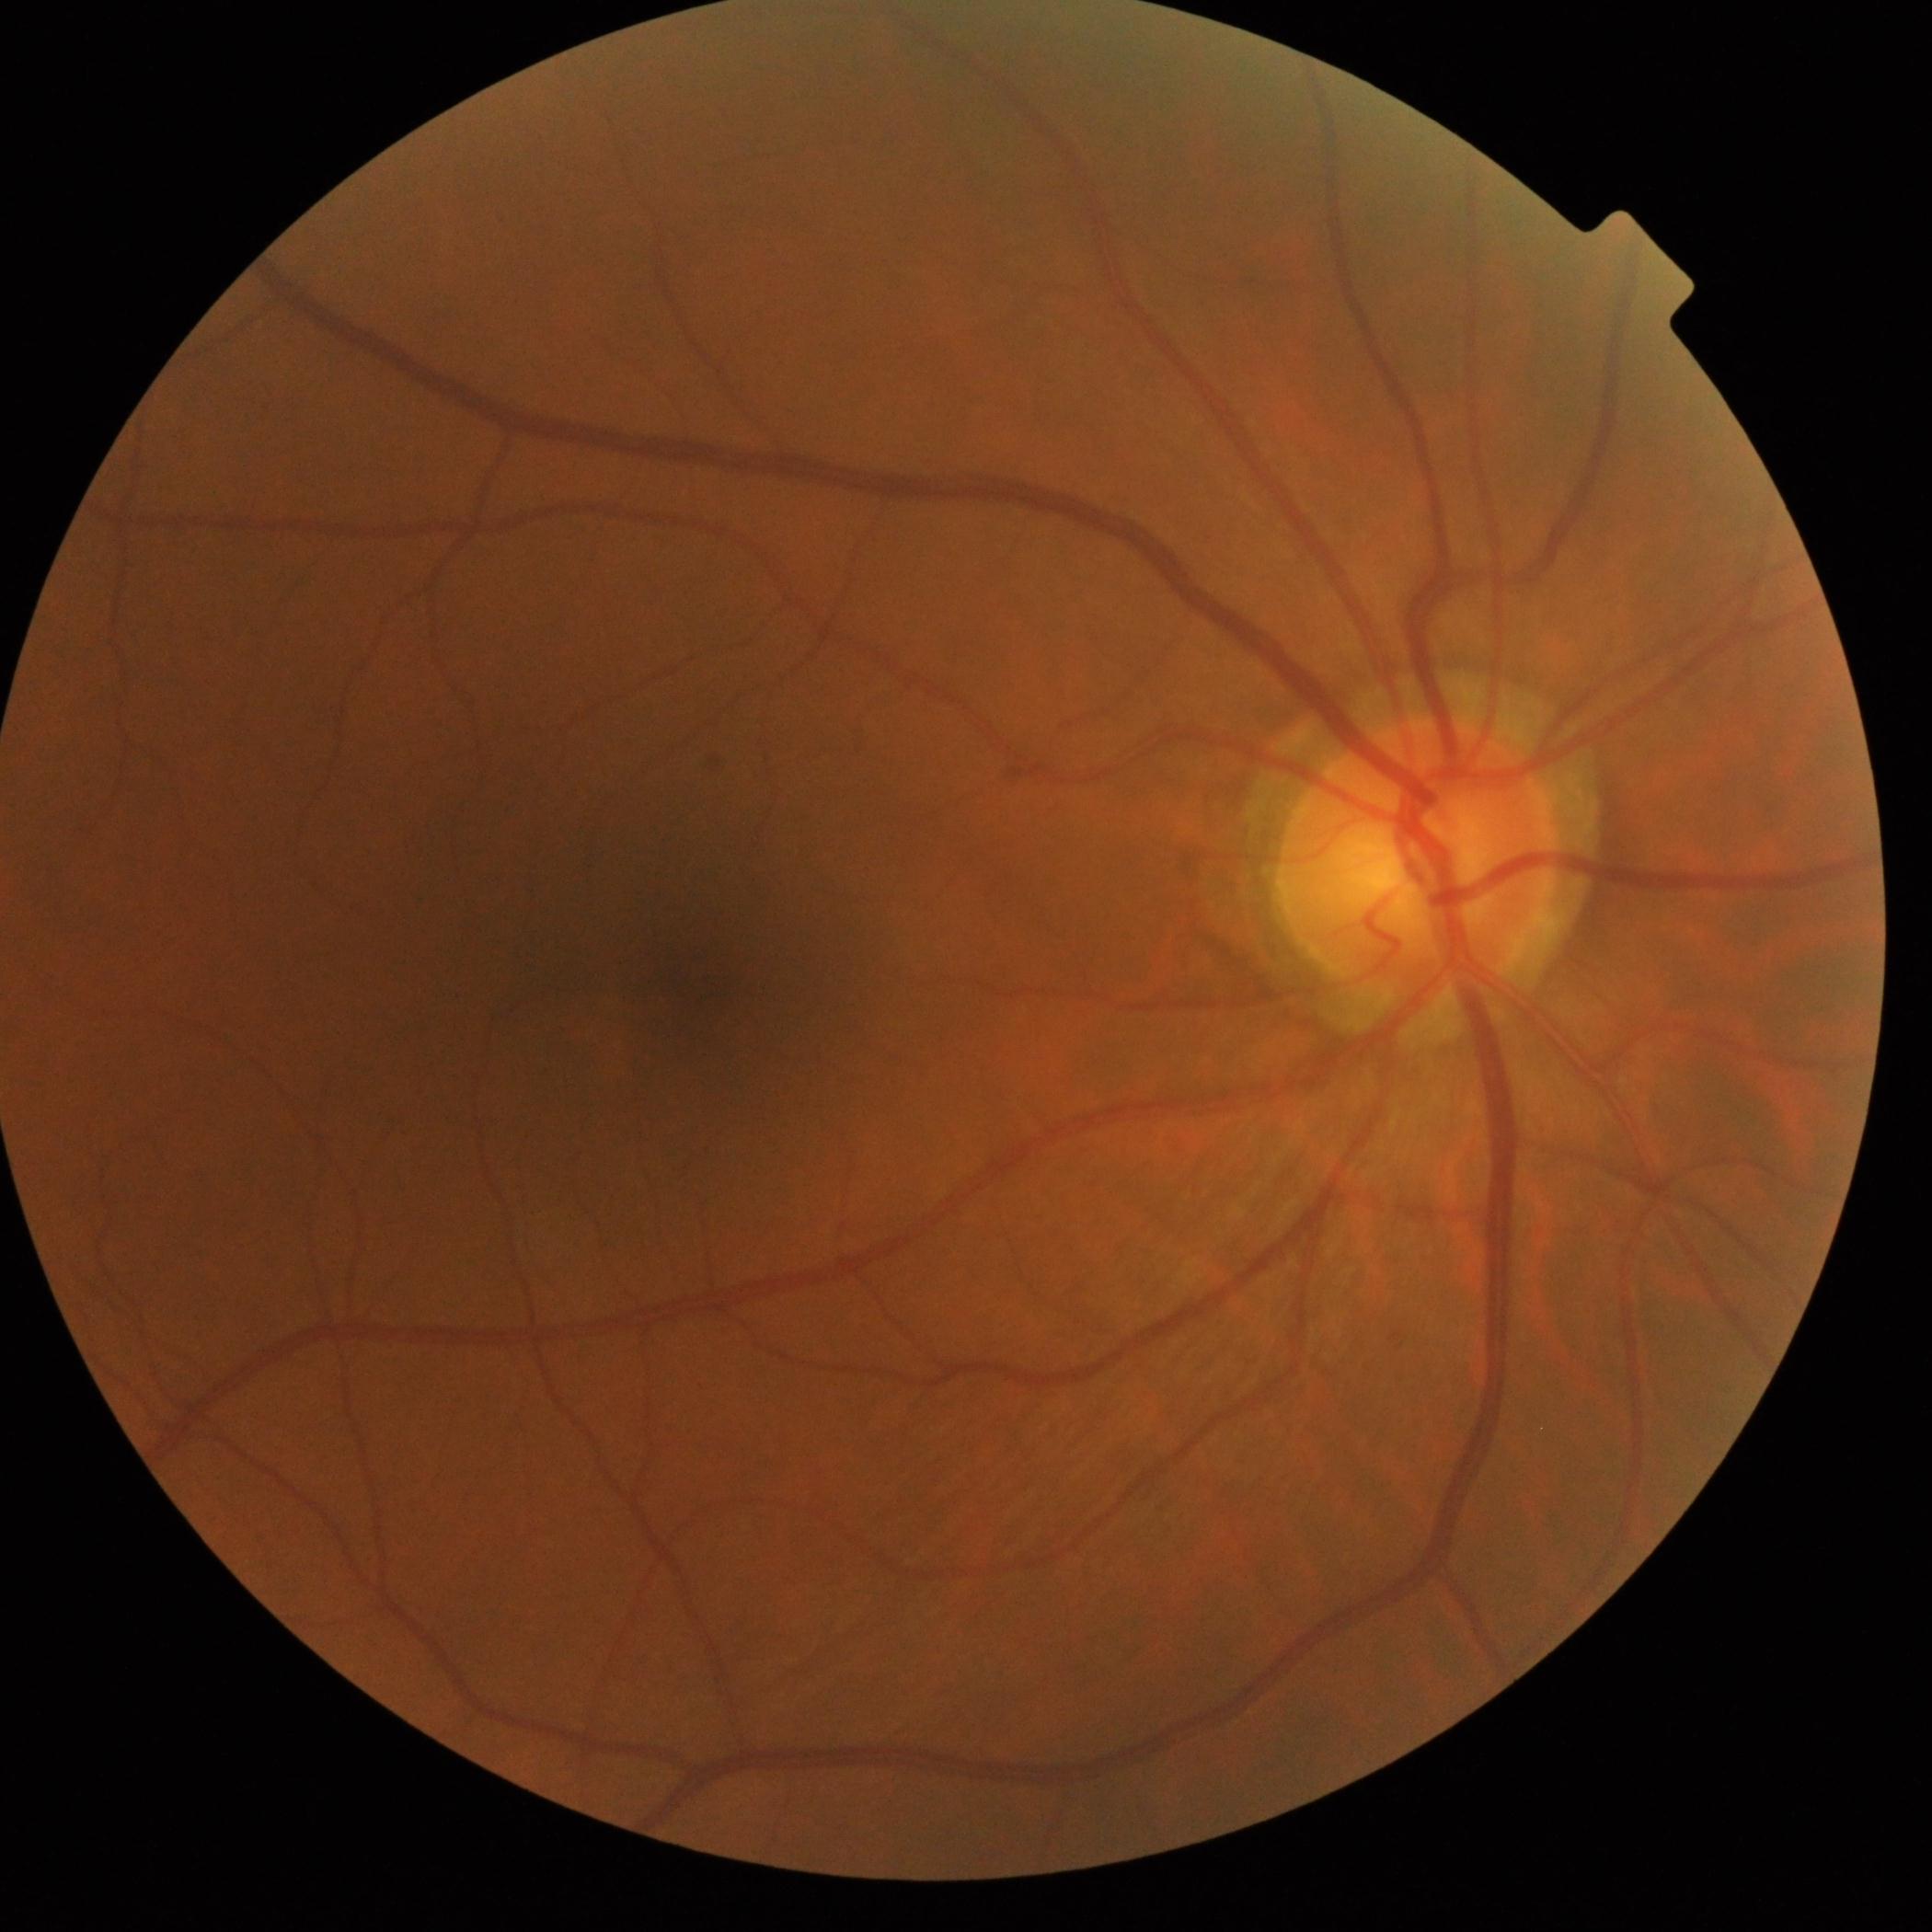

Findings:
- diabetic retinopathy grade: 0 (no apparent retinopathy)